NIDEK AFC-230.
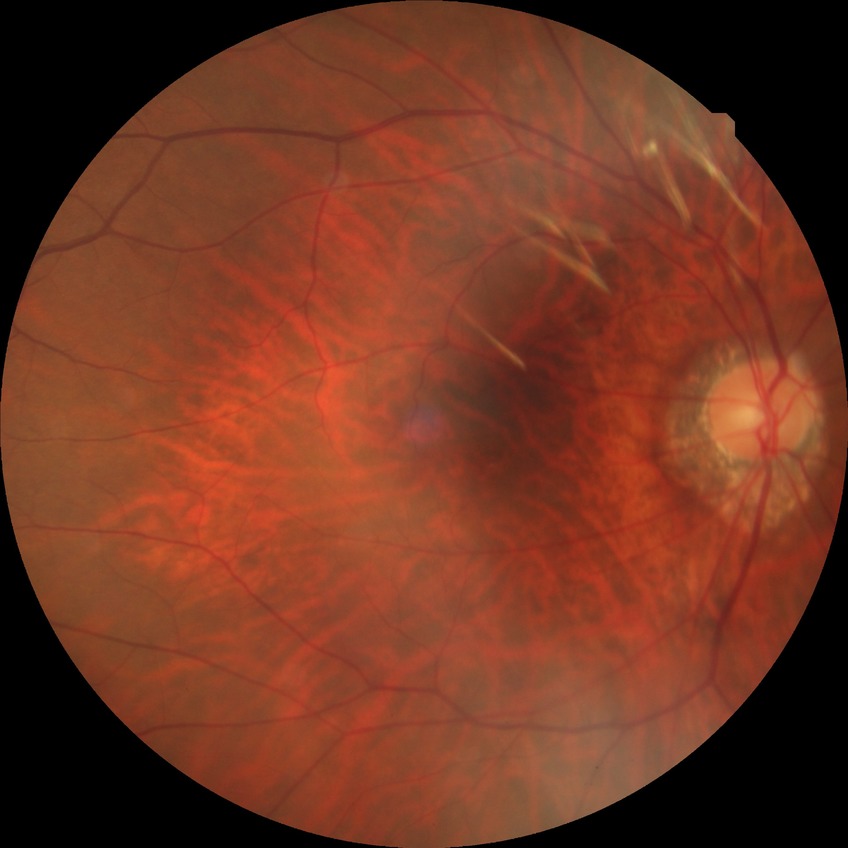 {
  "davis_grade": "no diabetic retinopathy"
}